Fundus photo · 2048 by 1536 pixels · 45° FOV:
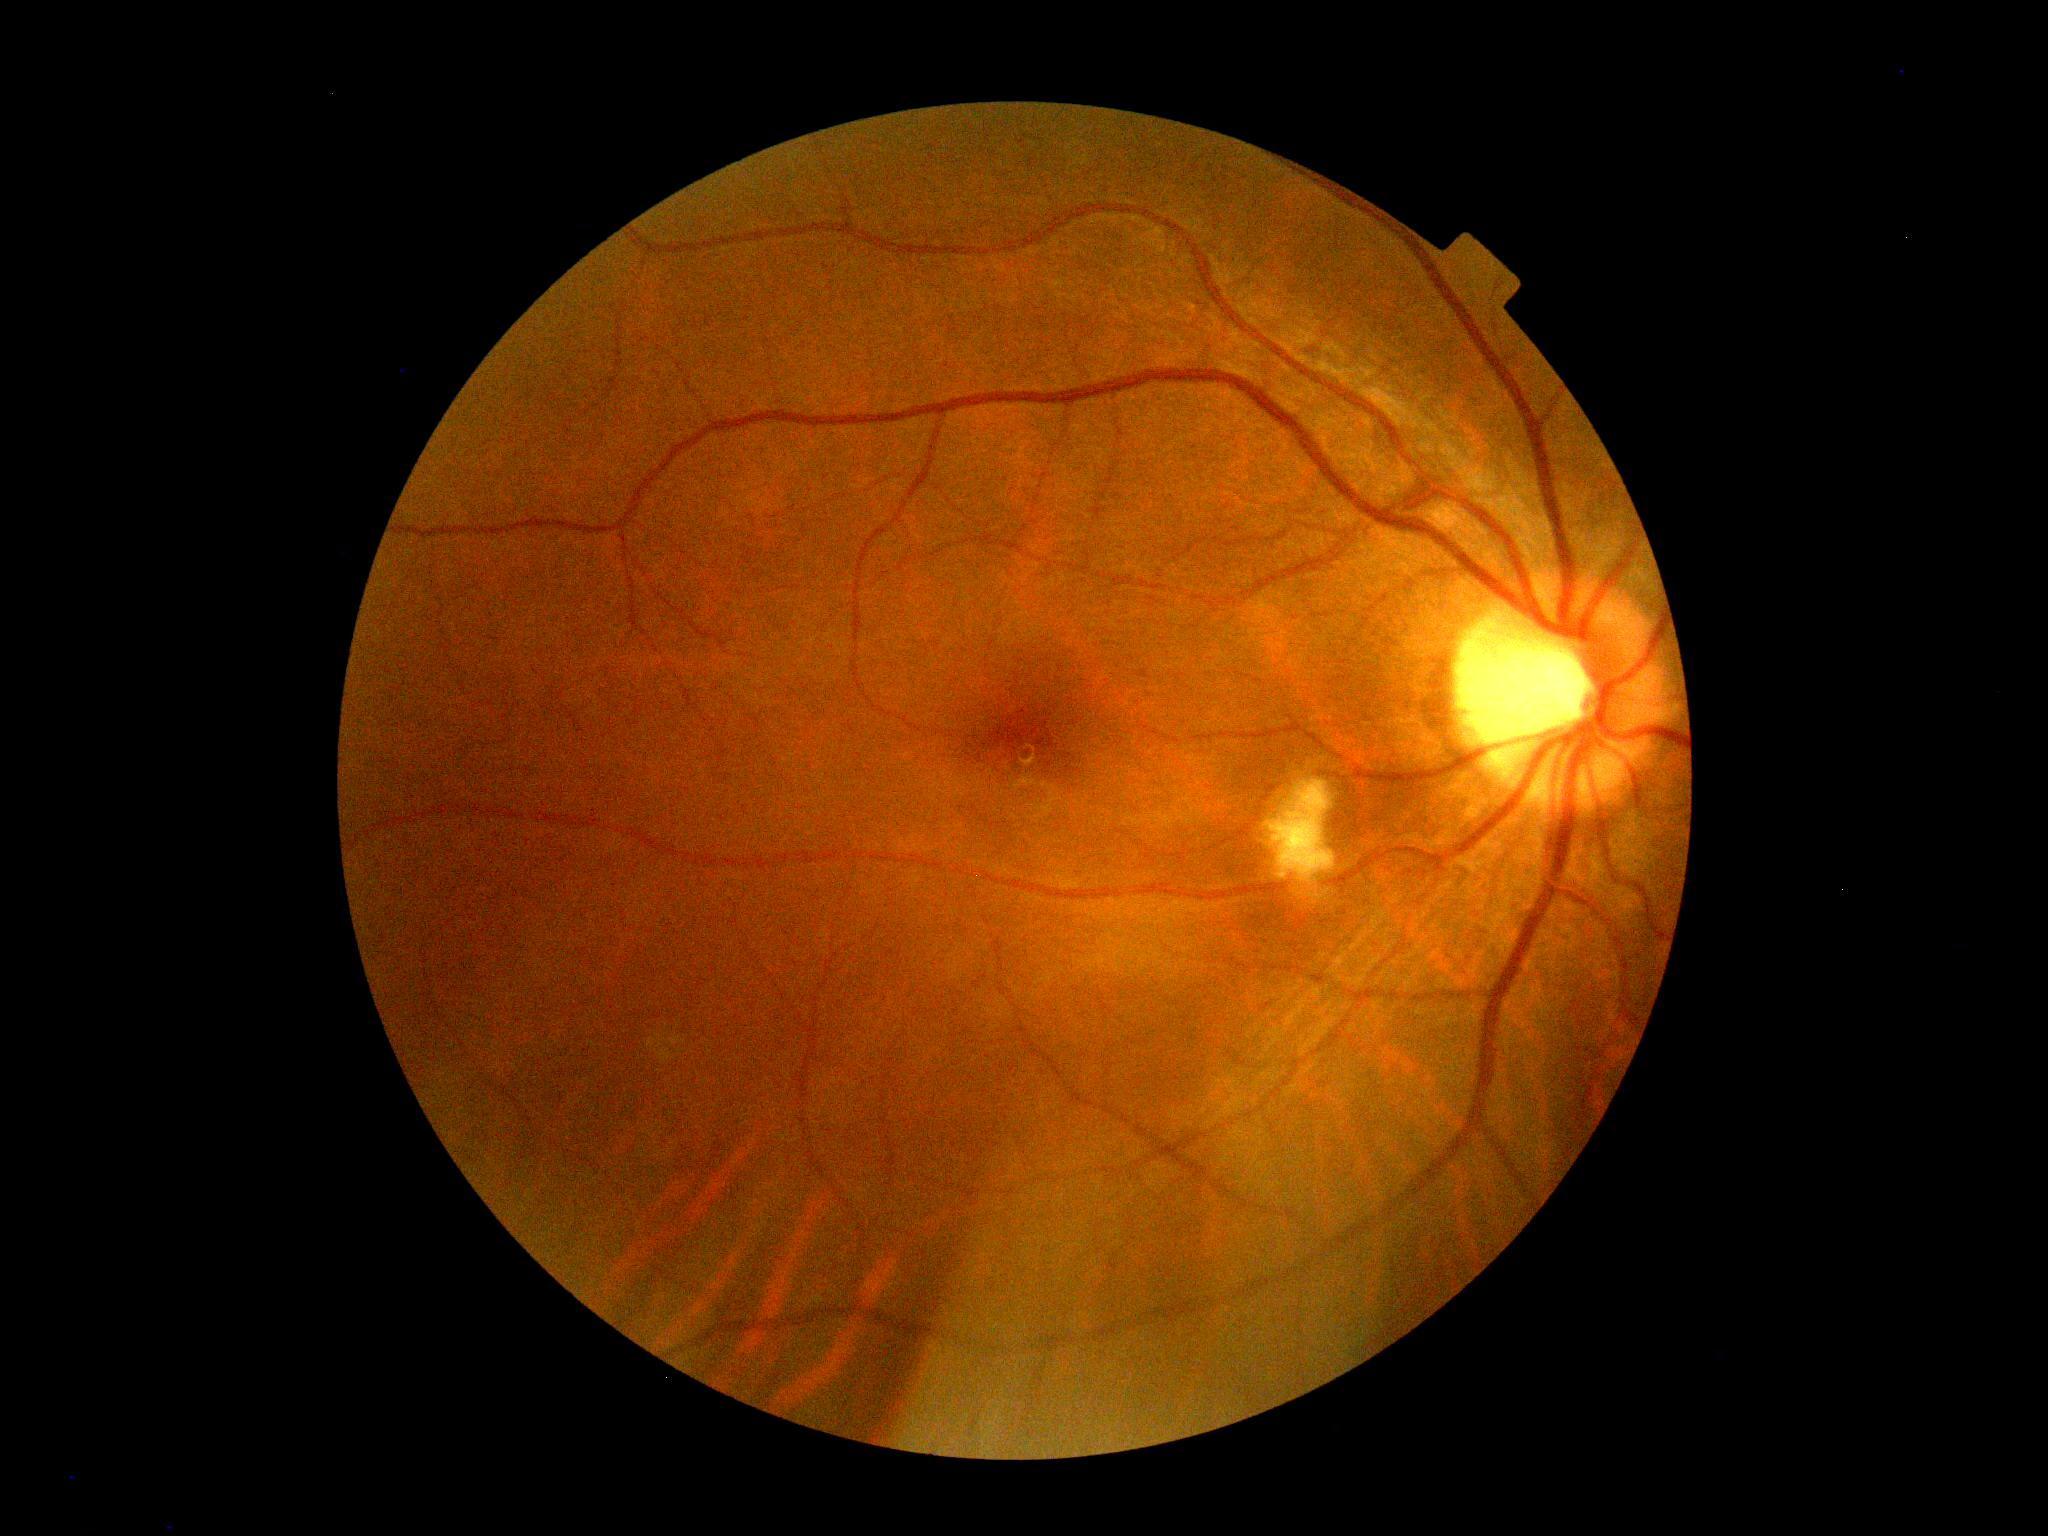

Diabetic retinopathy is moderate non-proliferative diabetic retinopathy (grade 2) — more than just microaneurysms but less than severe NPDR.